Camera: Clarity RetCam 3 (130° FOV) · RetCam wide-field infant fundus image — 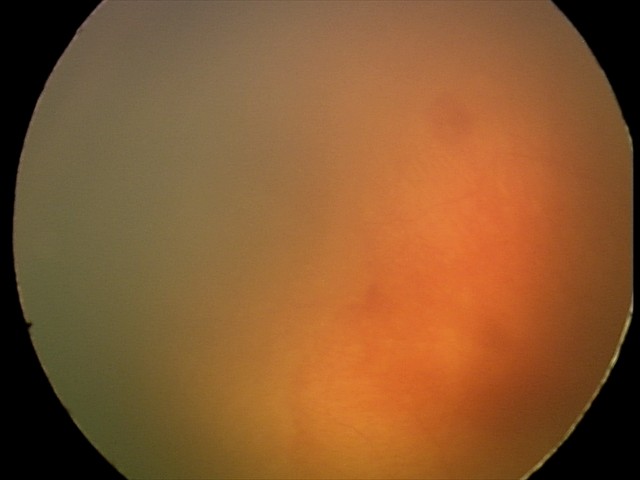 Screening examination consistent with aggressive retinopathy of prematurity.